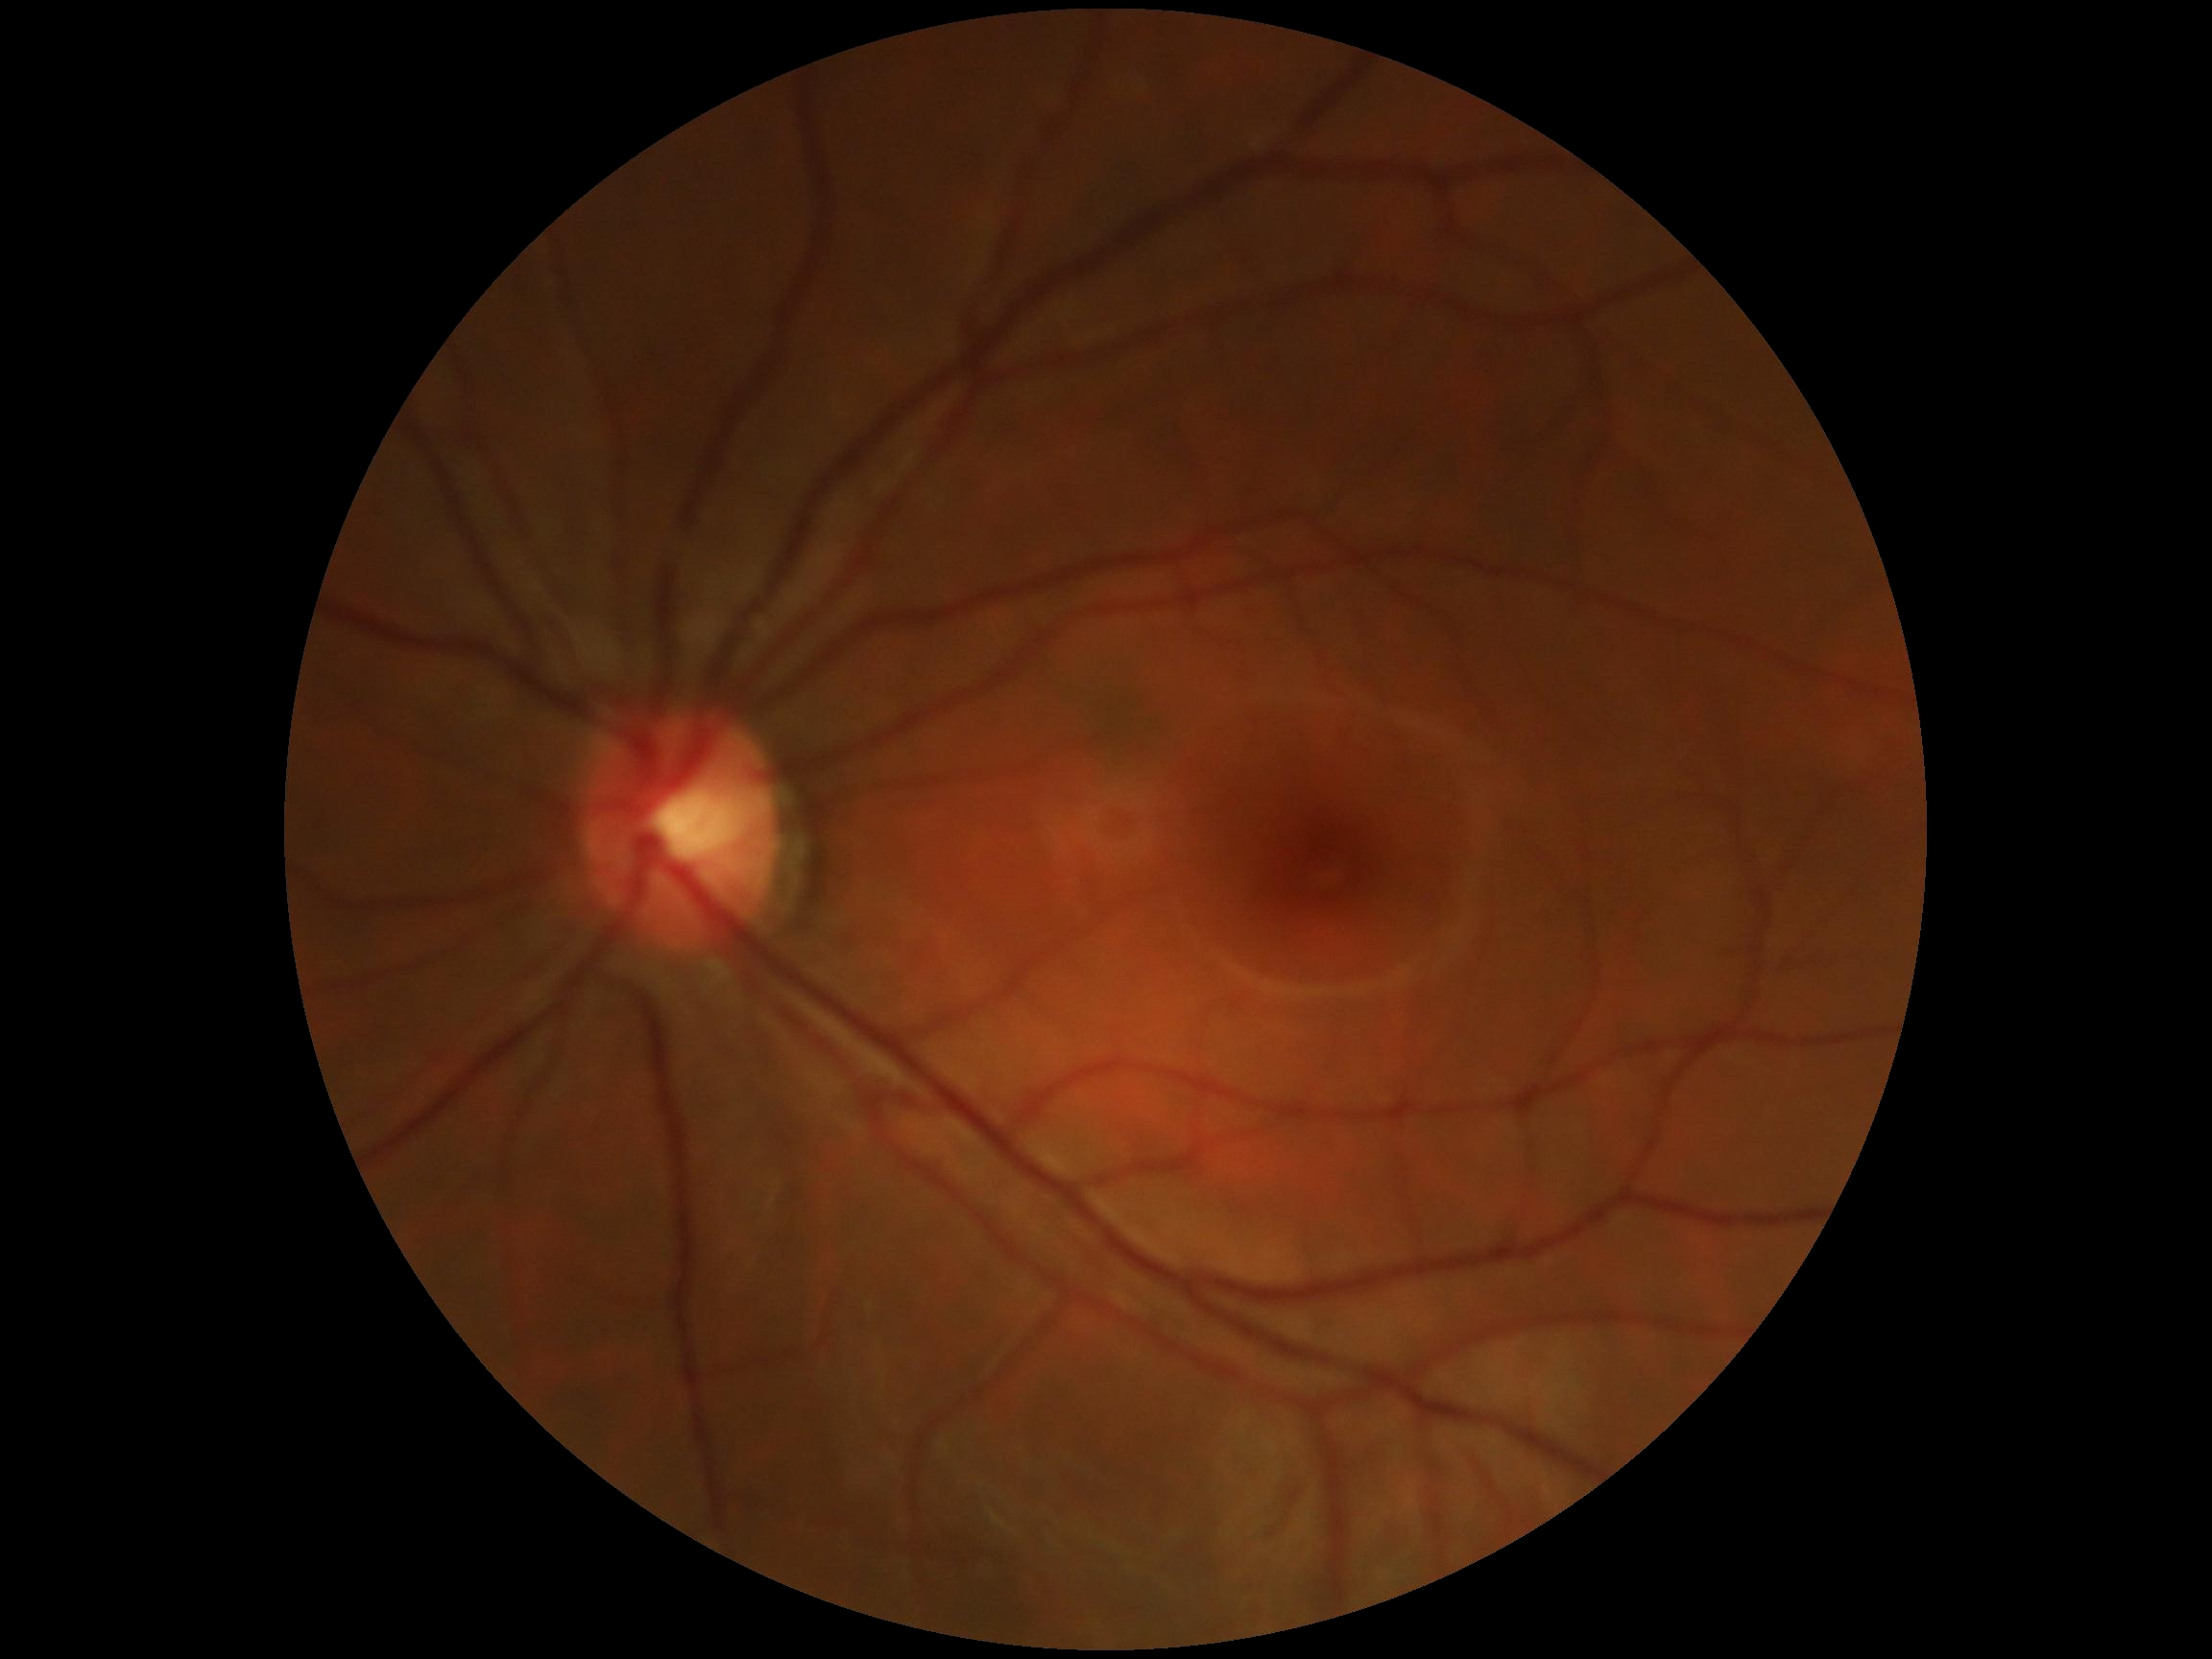 Diabetic retinopathy (DR): grade 0 (no apparent retinopathy). No DR findings.